Fundus photo; 45-degree field of view
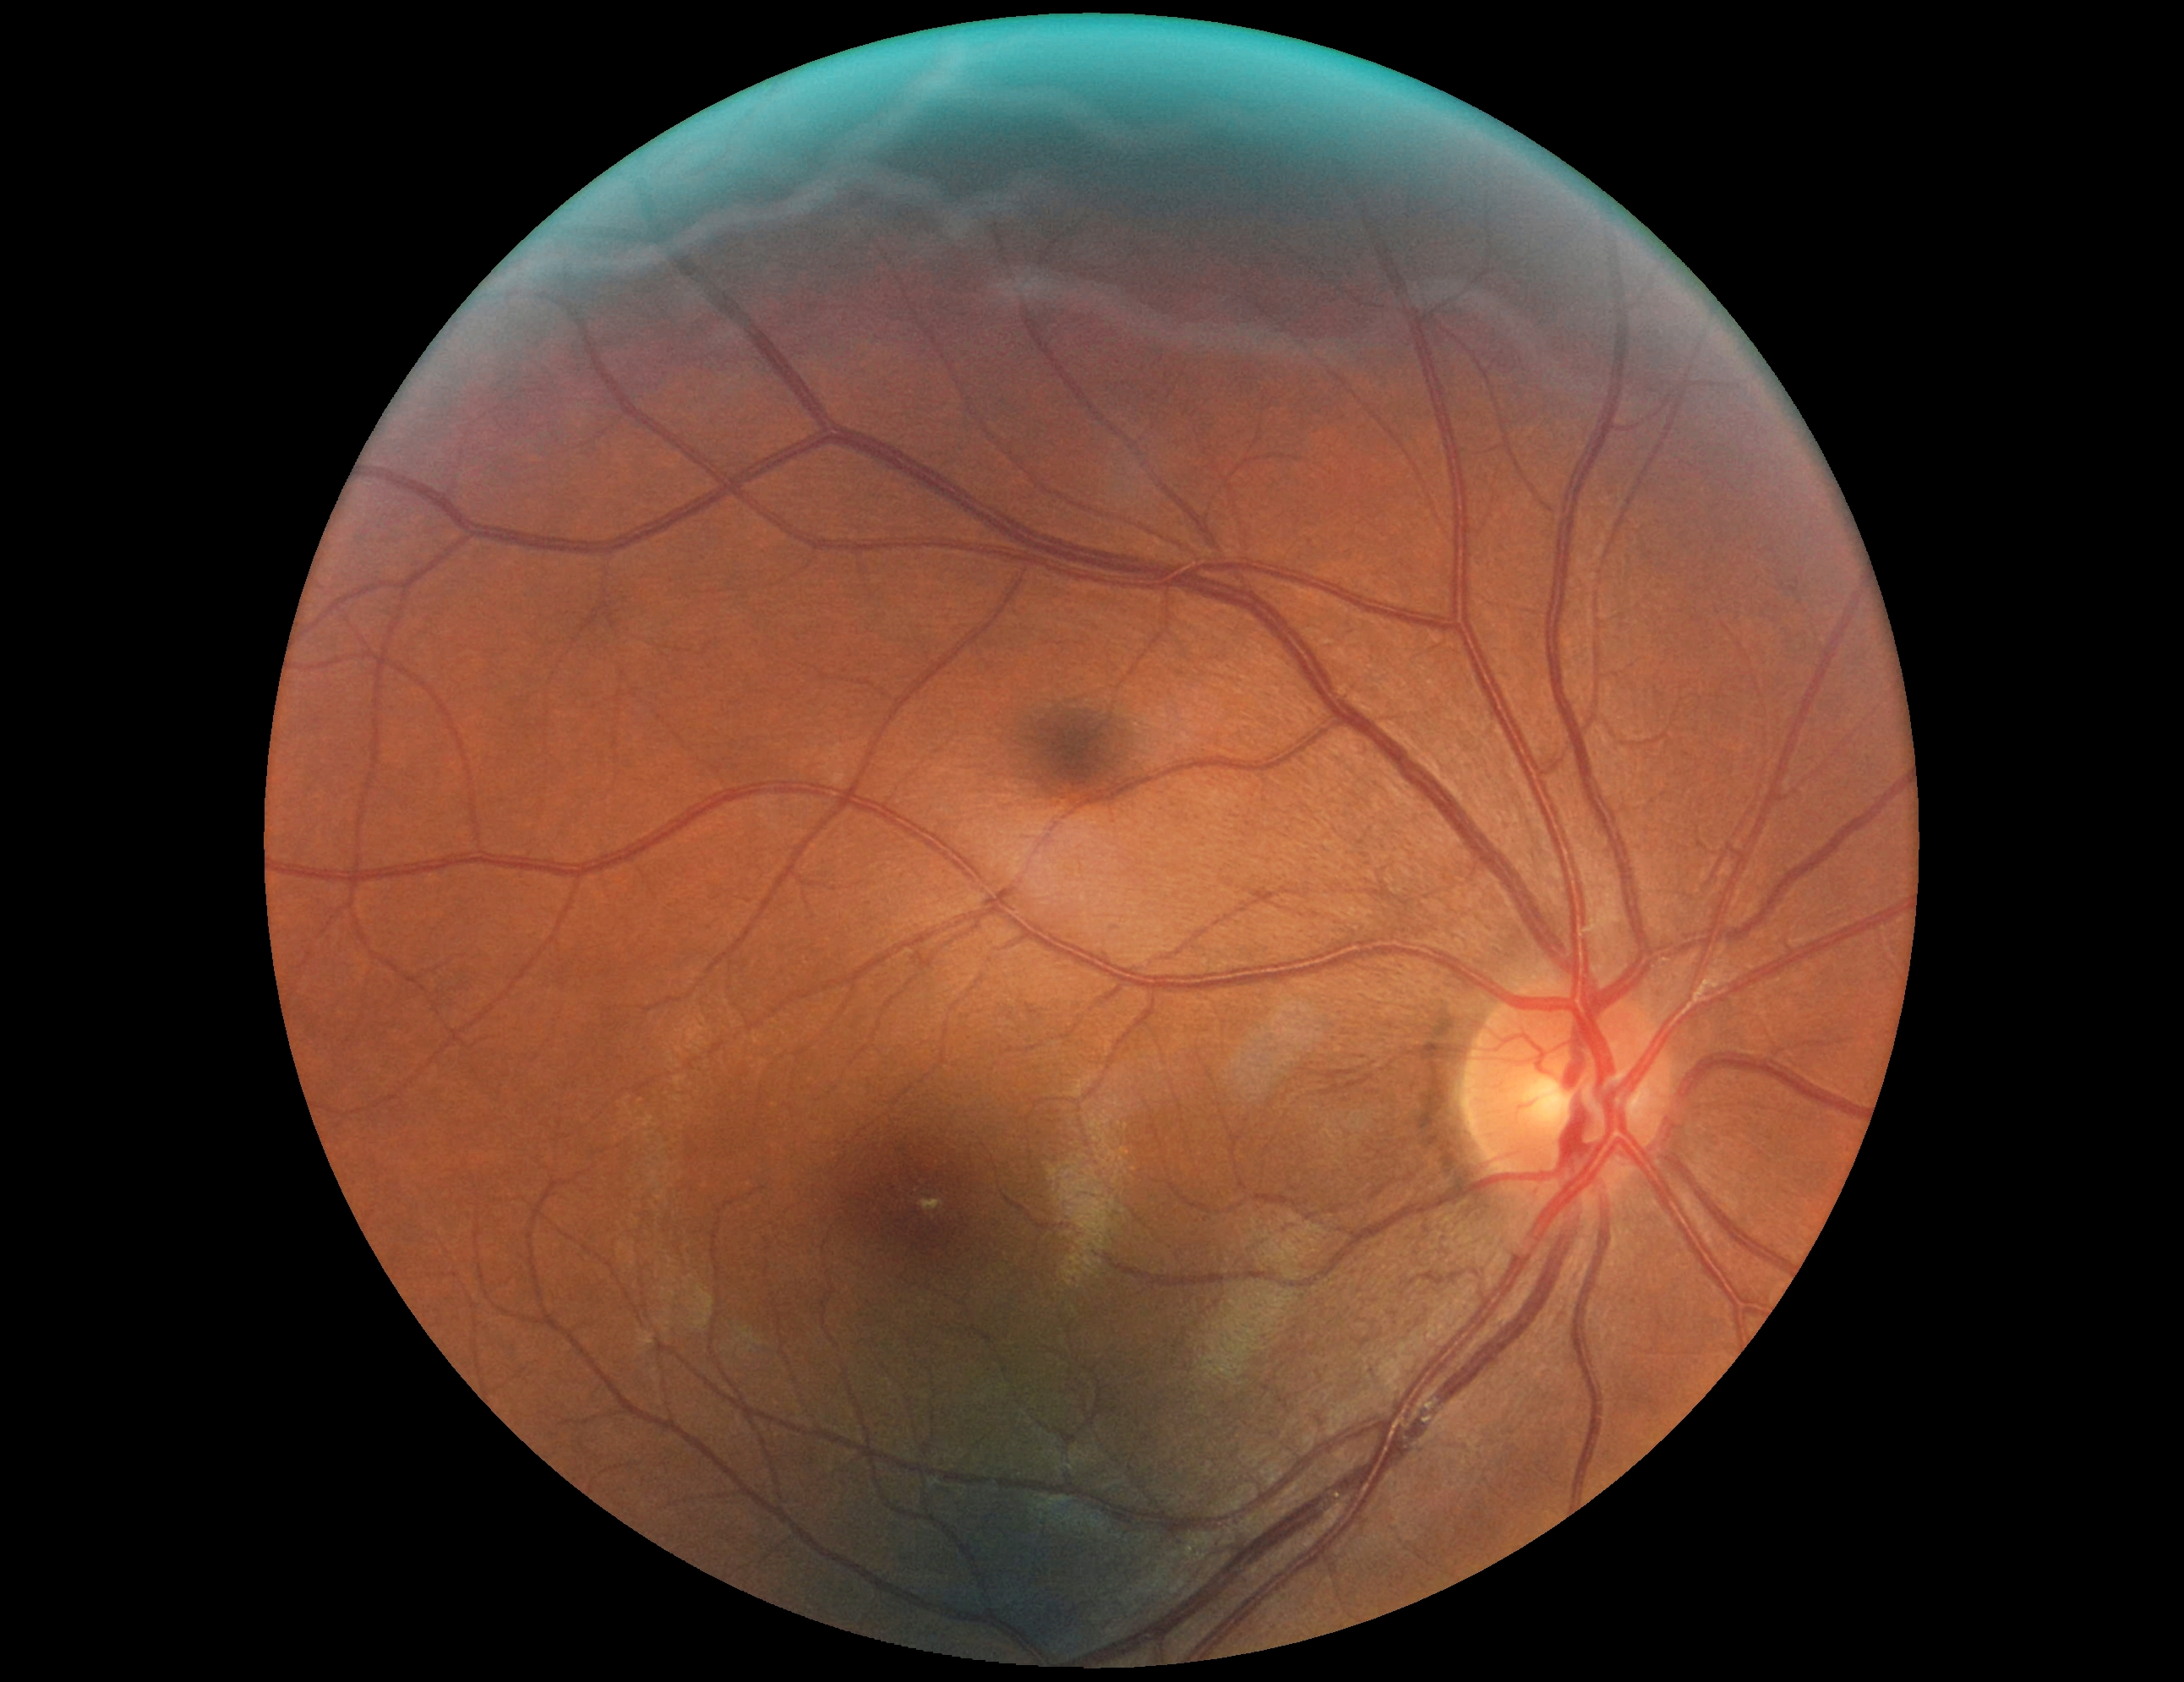
{
  "dr_grade": "0 (no apparent retinopathy)"
}